45° field of view.
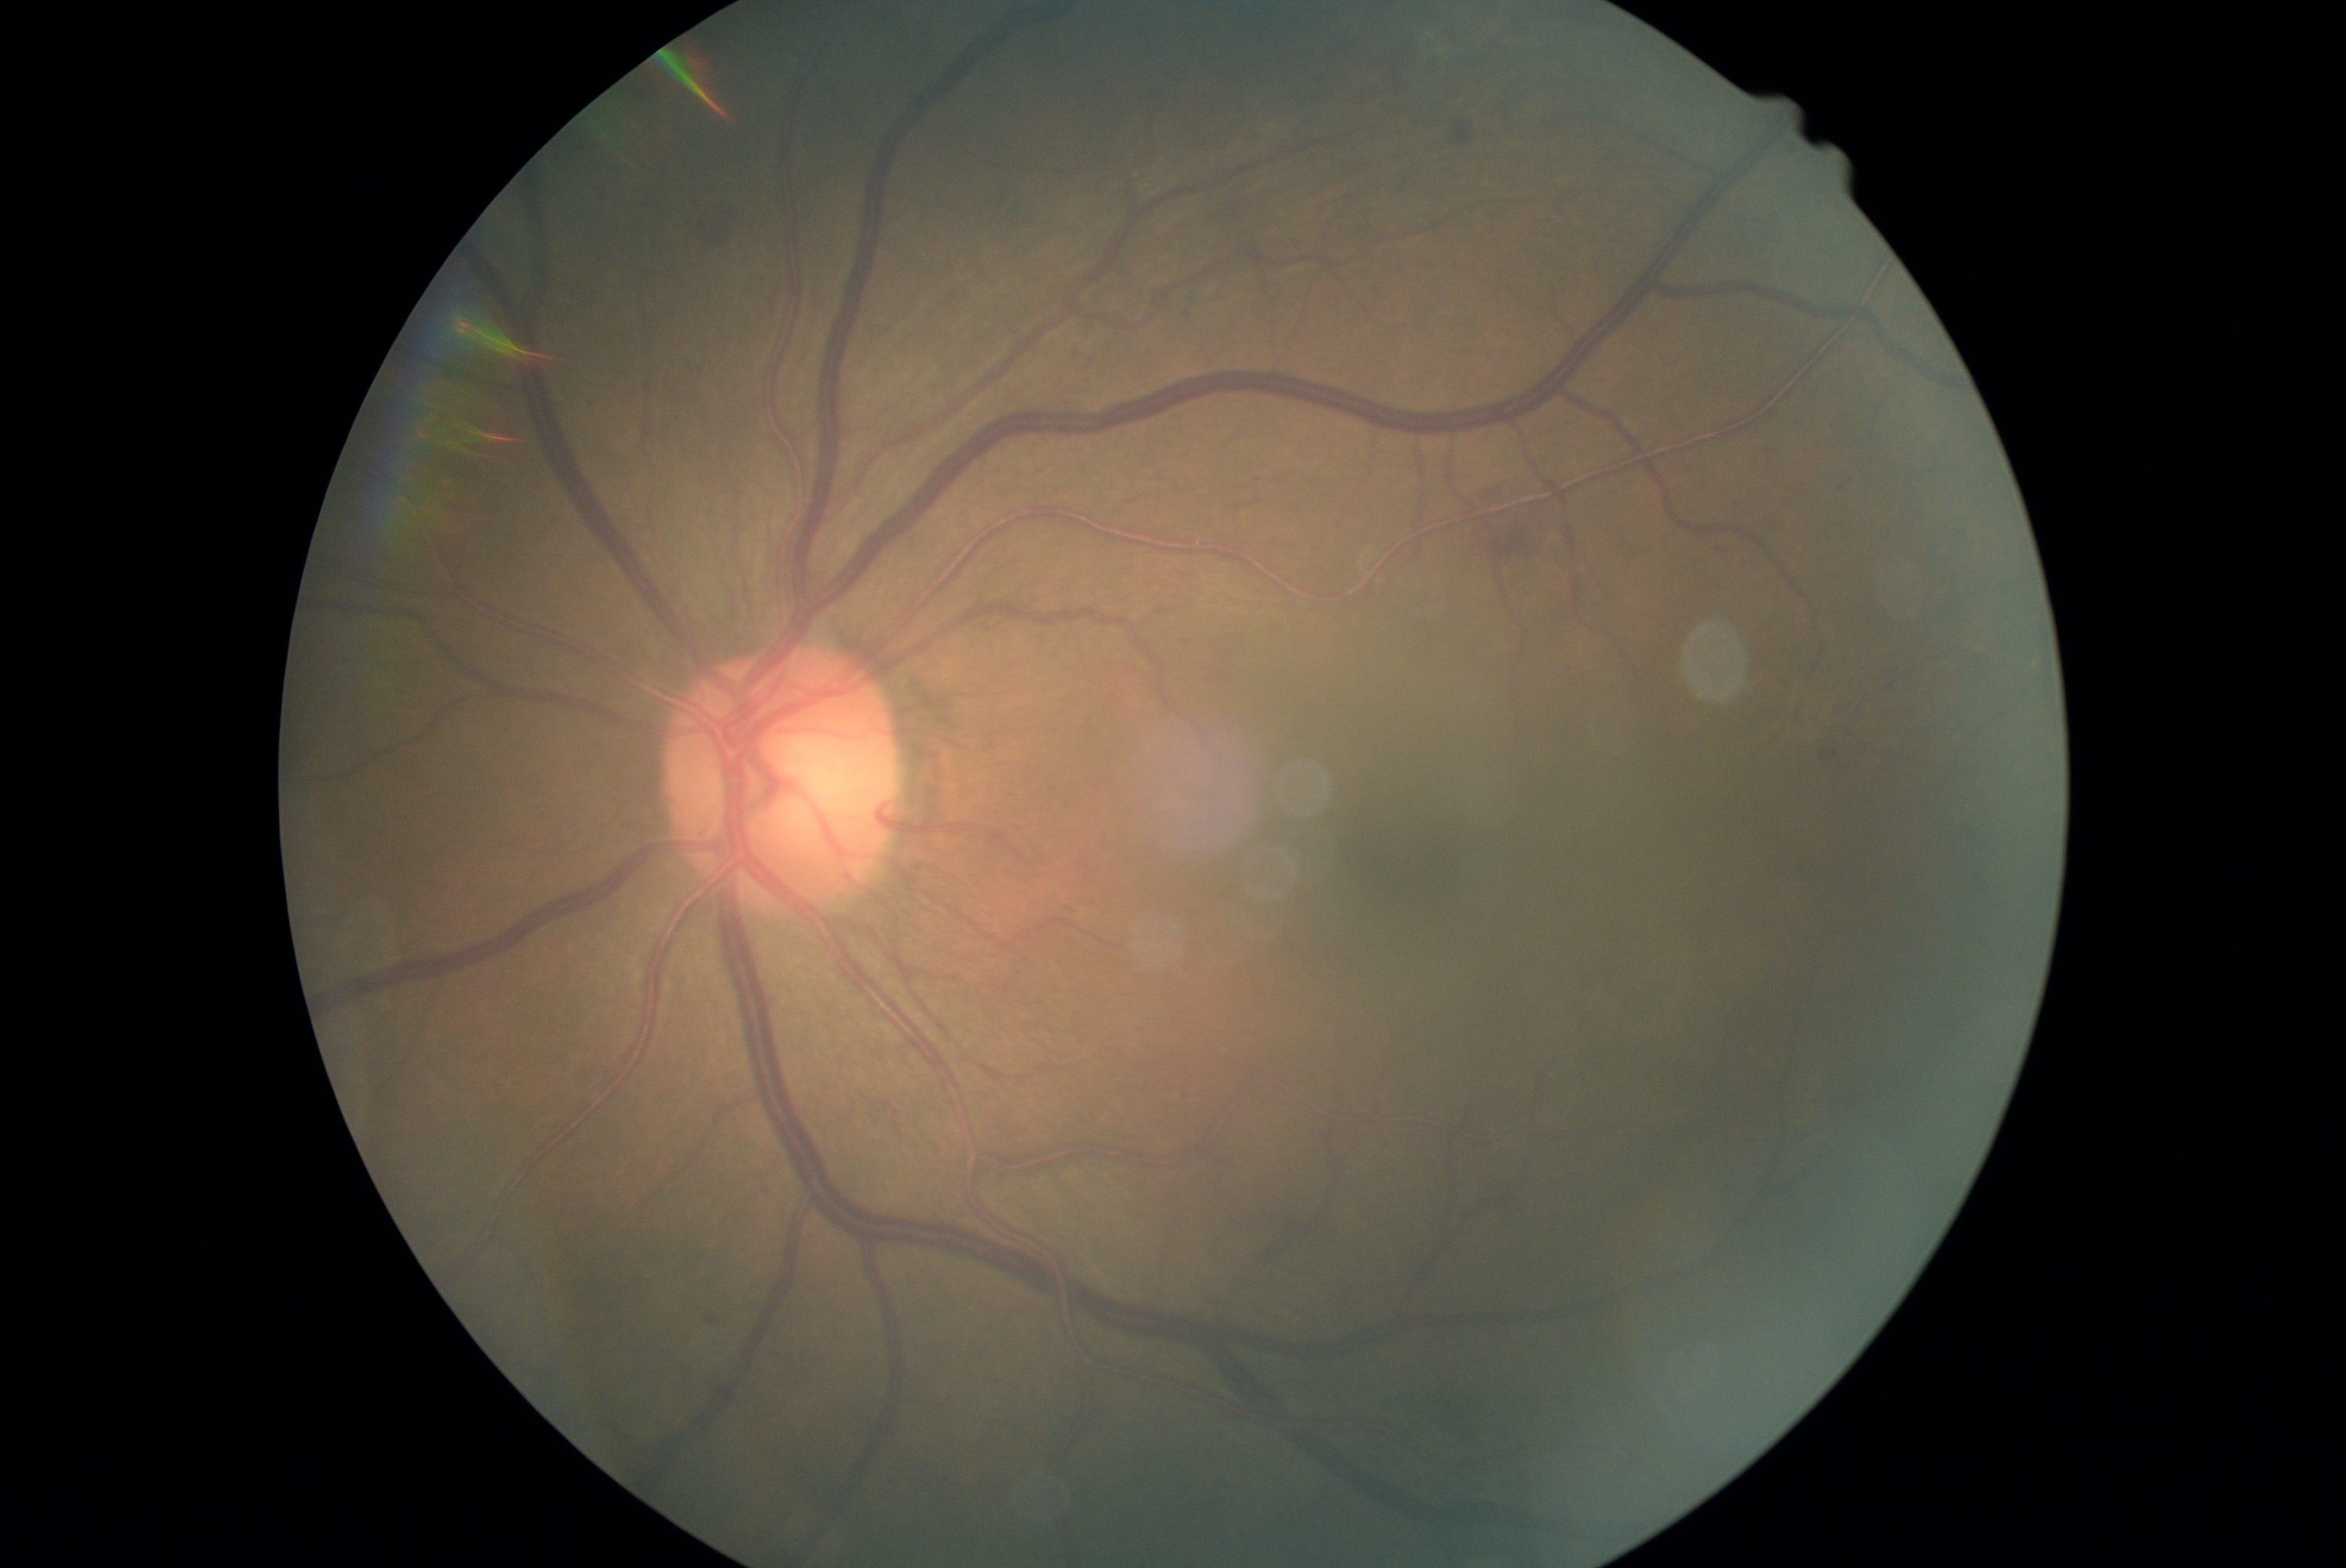

* diabetic retinopathy (DR) — 2/4